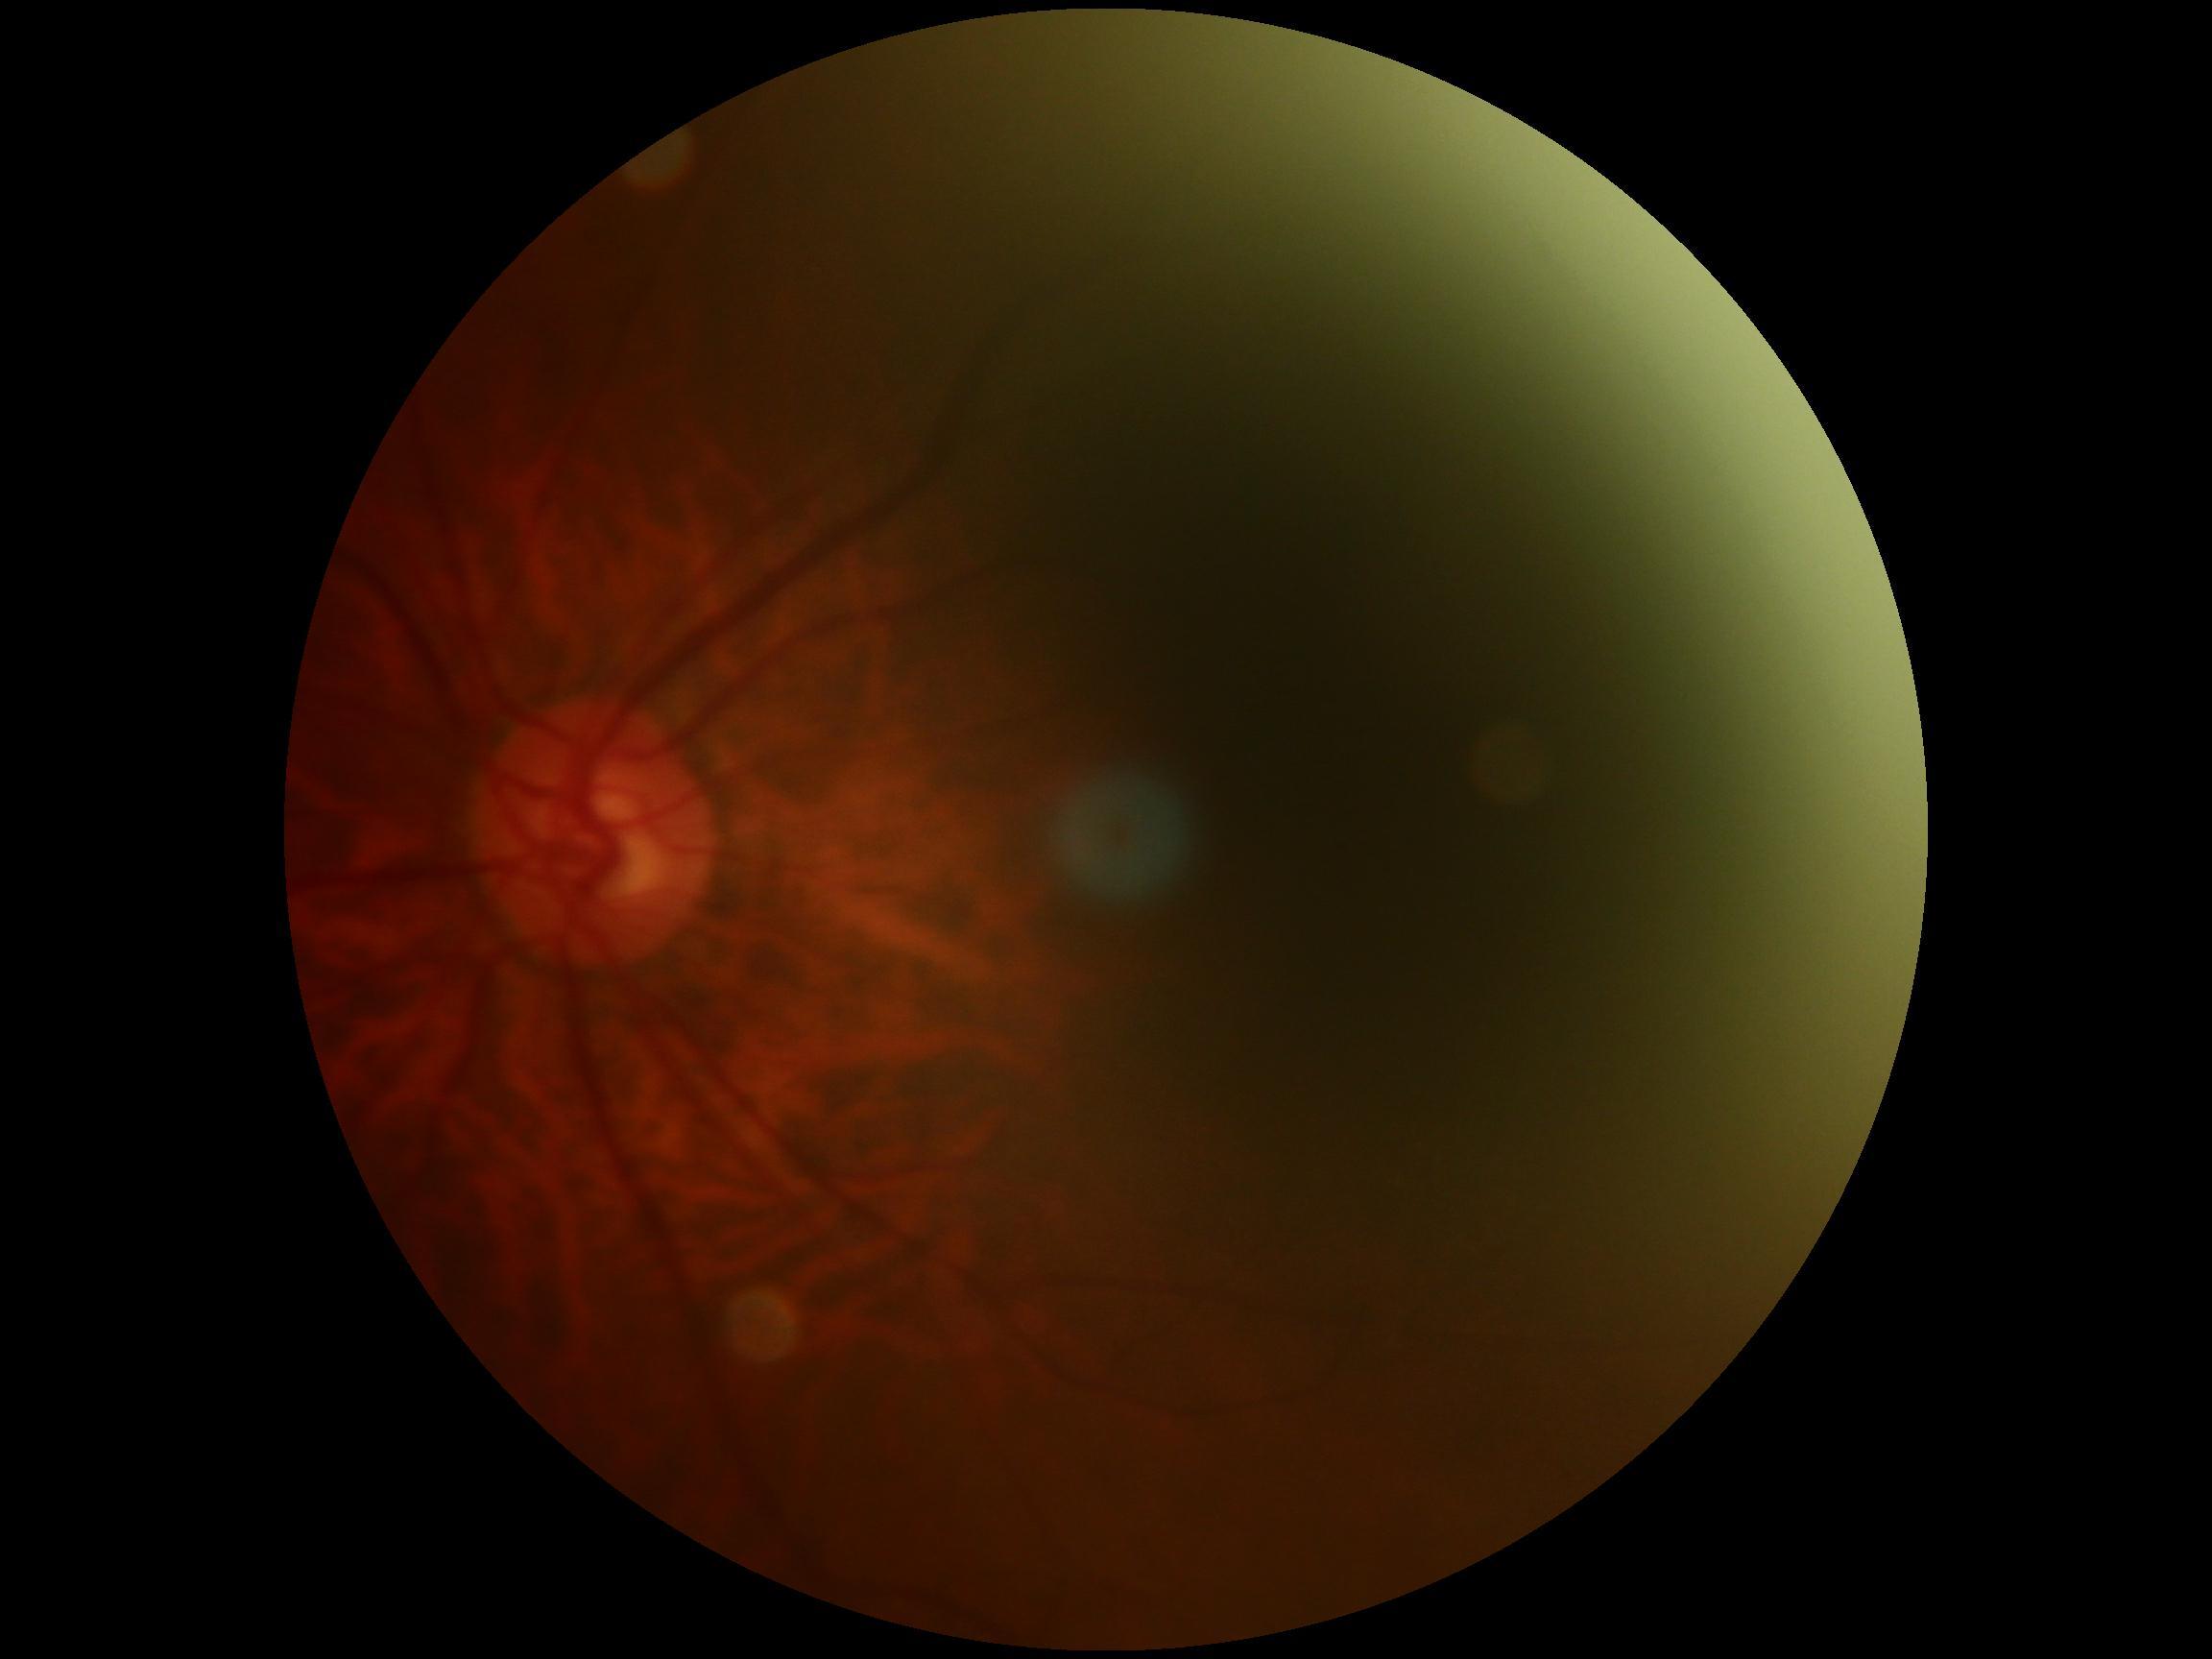

image quality: insufficient
DR stage: ungradable due to poor image quality